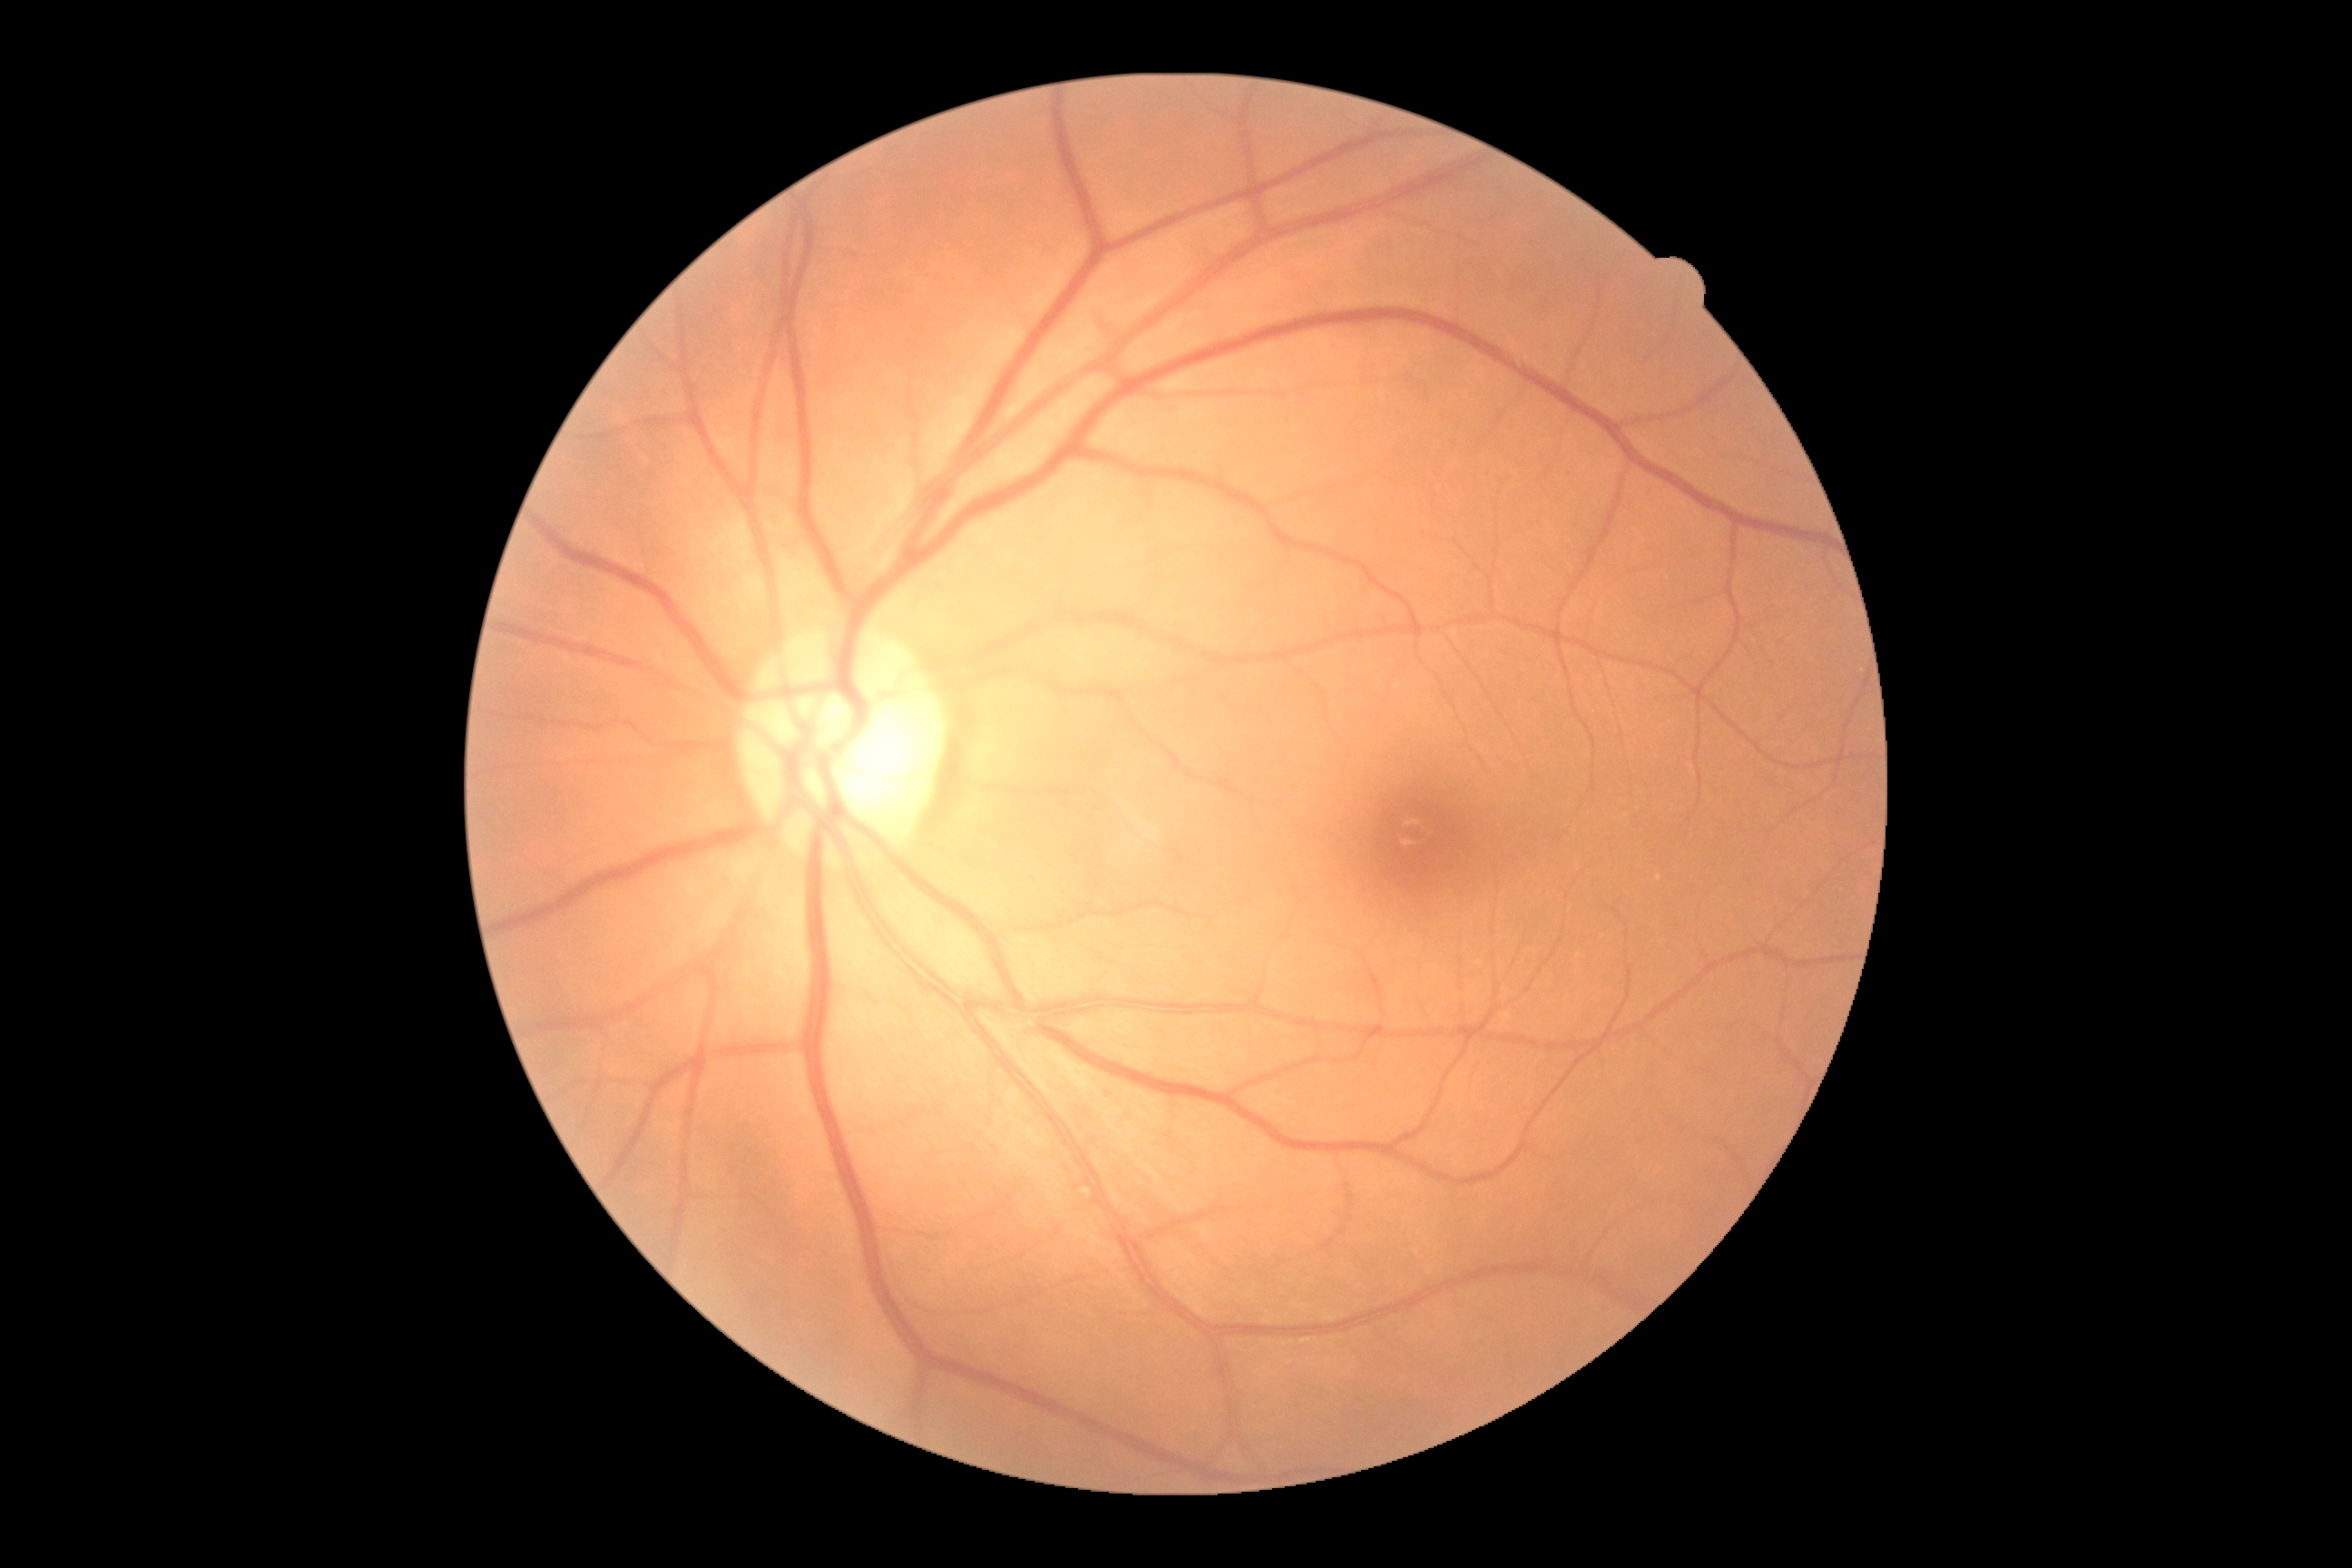 diabetic retinopathy (DR)@0; DR impression@no apparent DR.